Camera: NIDEK AFC-230. 848 by 848 pixels. 45-degree field of view. Color fundus photograph:
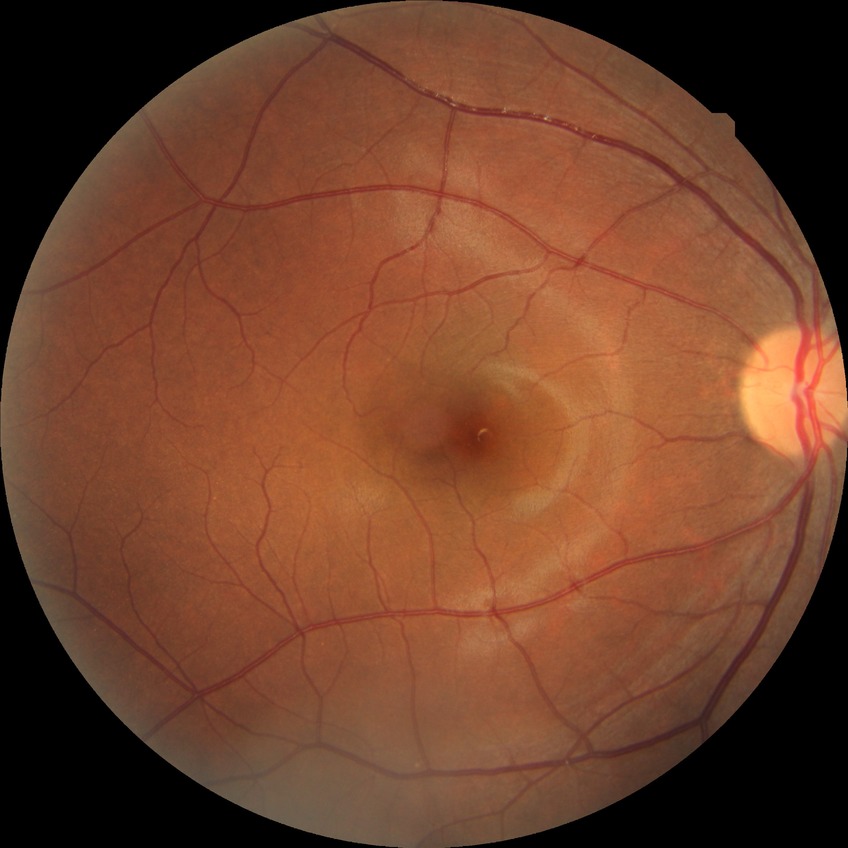
Diabetic retinopathy grade: no diabetic retinopathy.